Non-mydriatic fundus camera · centered on the optic disc
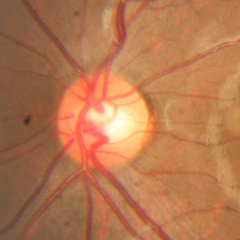

Q: Is glaucoma present?
A: No glaucoma.